Axial length: 22.83 mm; male patient; IOP 16 mmHg by applanation tonometry:
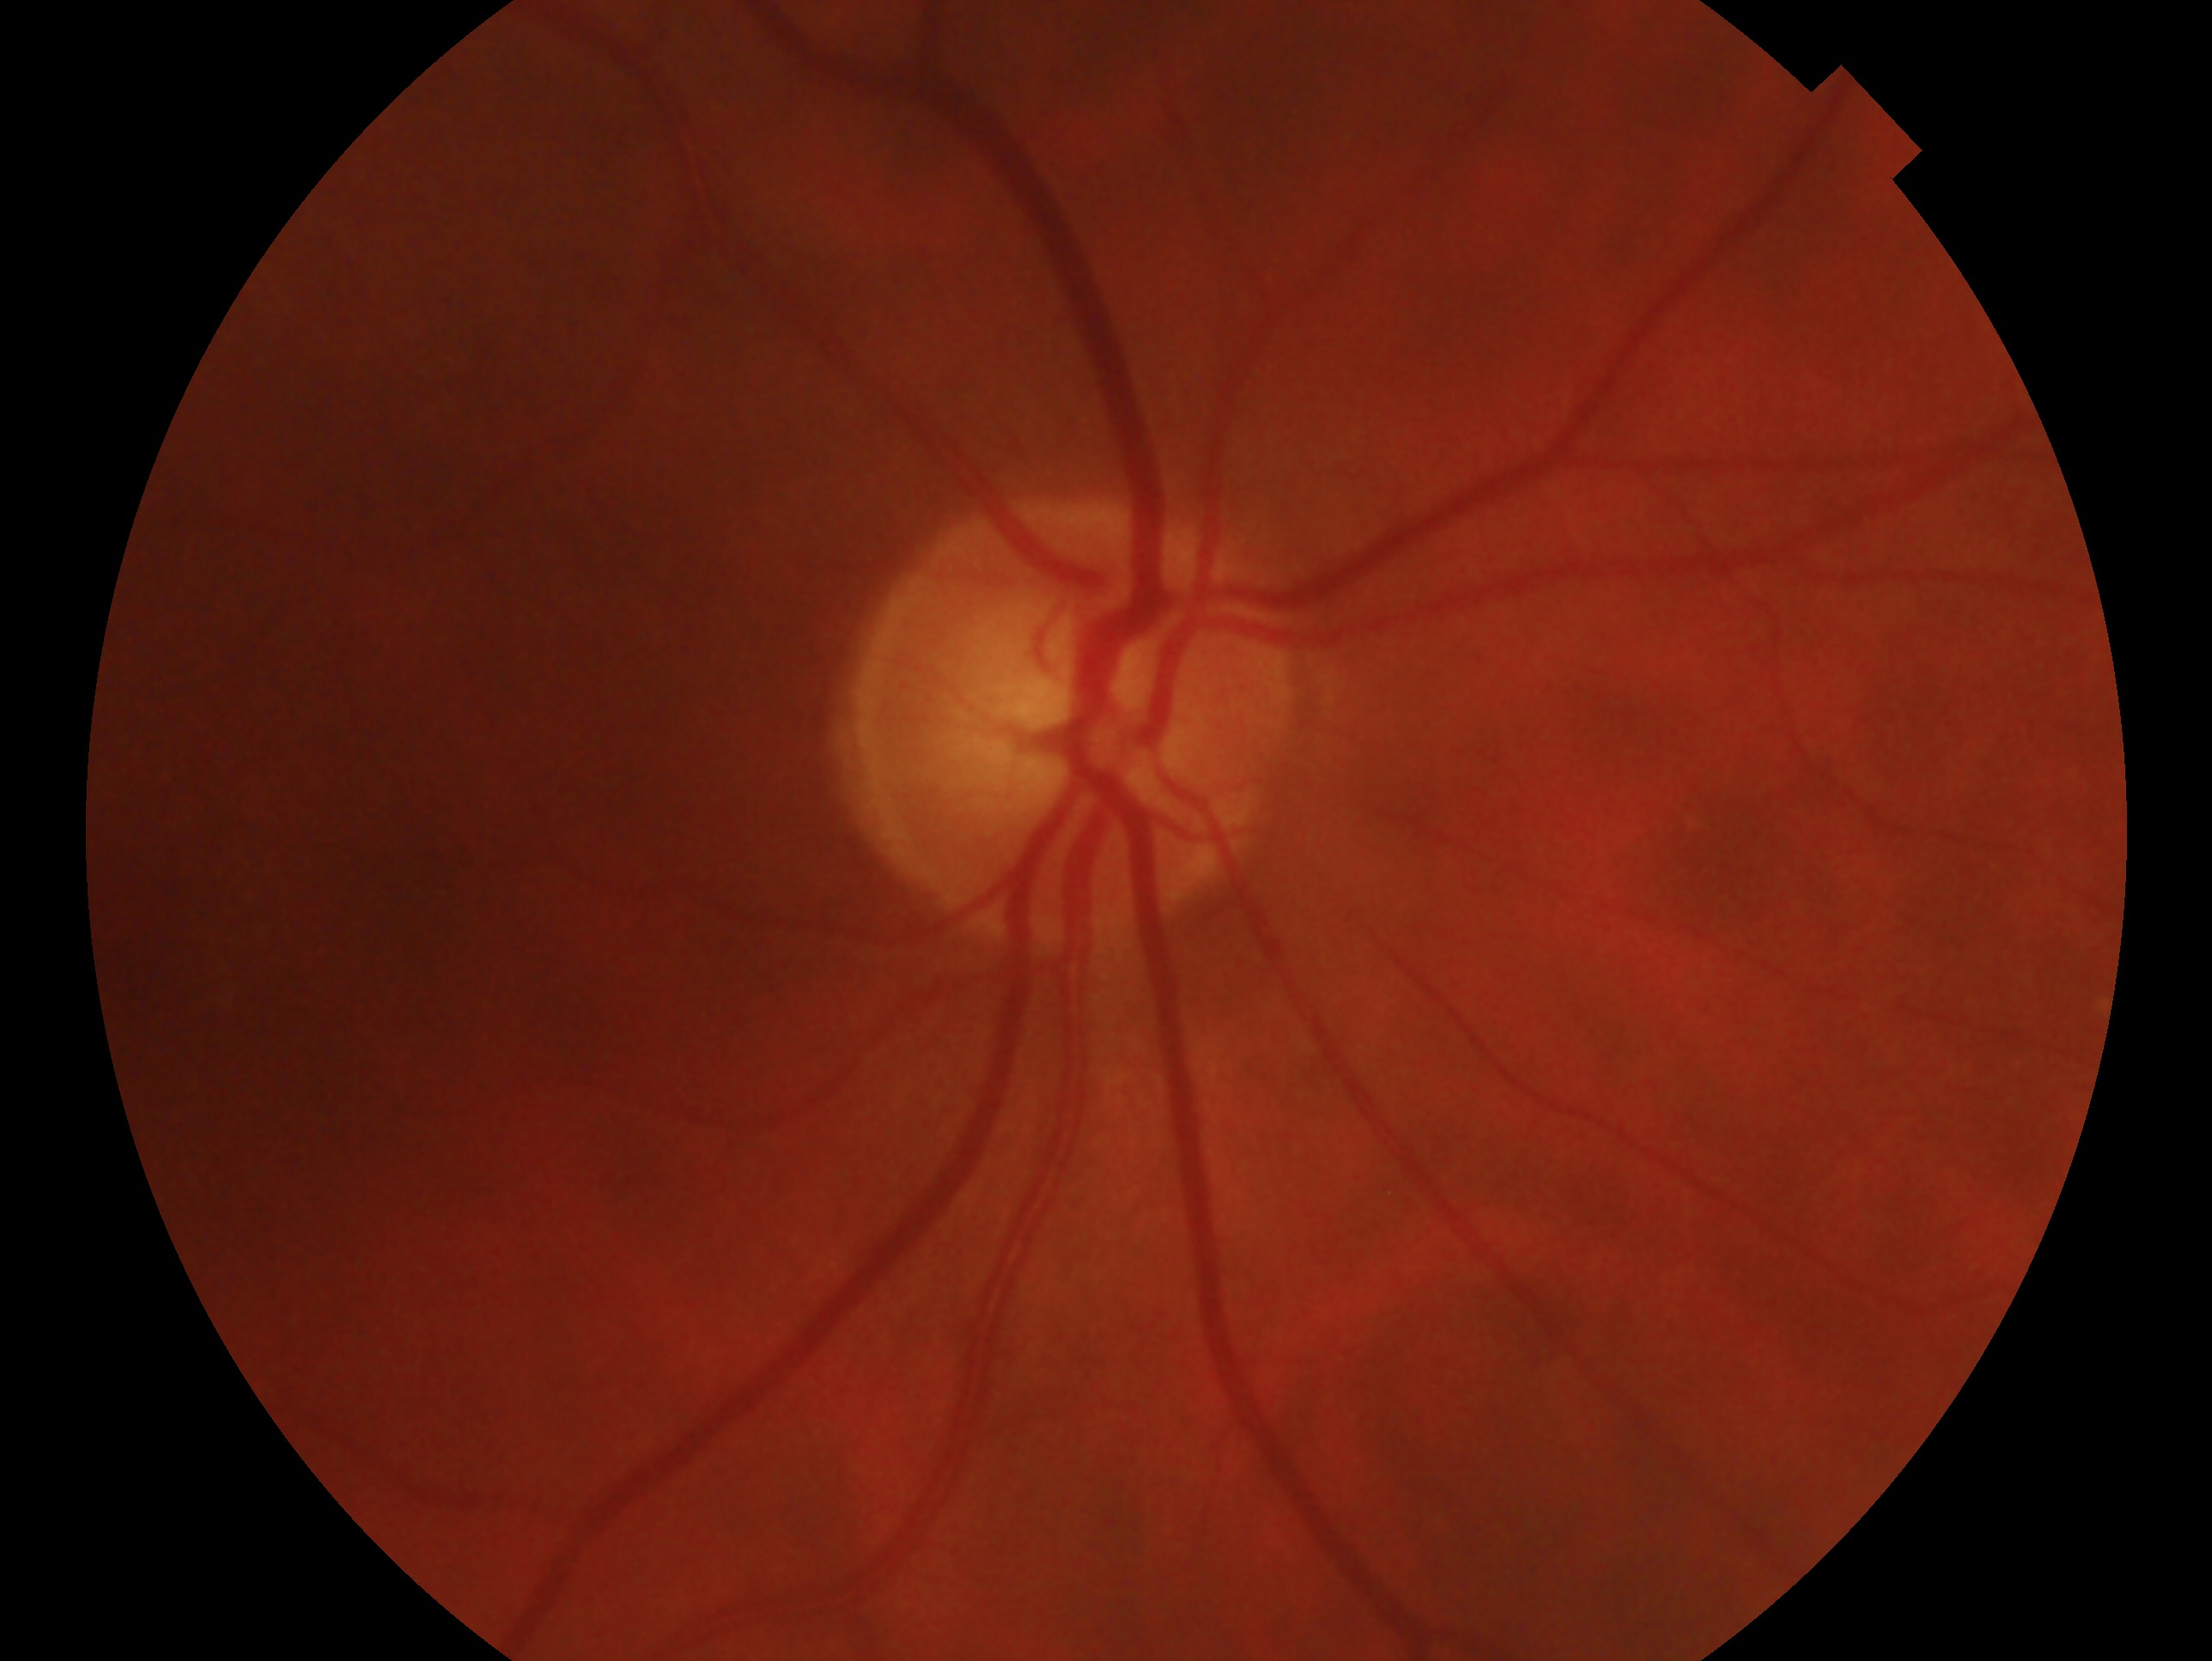
Glaucoma diagnosis — negative for glaucoma.
Imaged eye: OD.